Infant wide-field fundus photograph; Clarity RetCam 3, 130° FOV
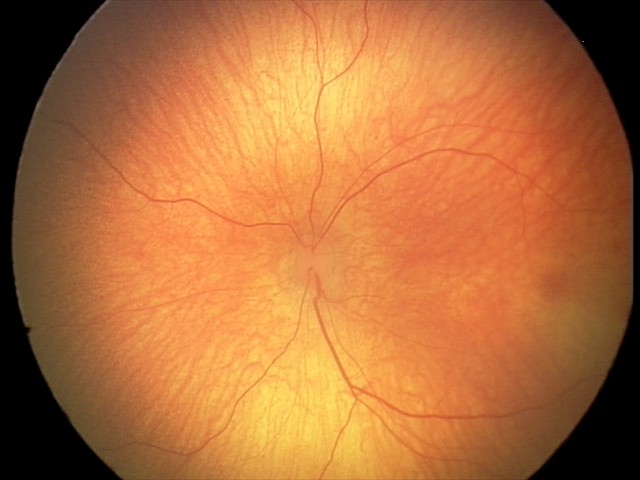 Normal screening examination.